NIDEK AFC-230 fundus camera · 45° FOV · modified Davis grading: 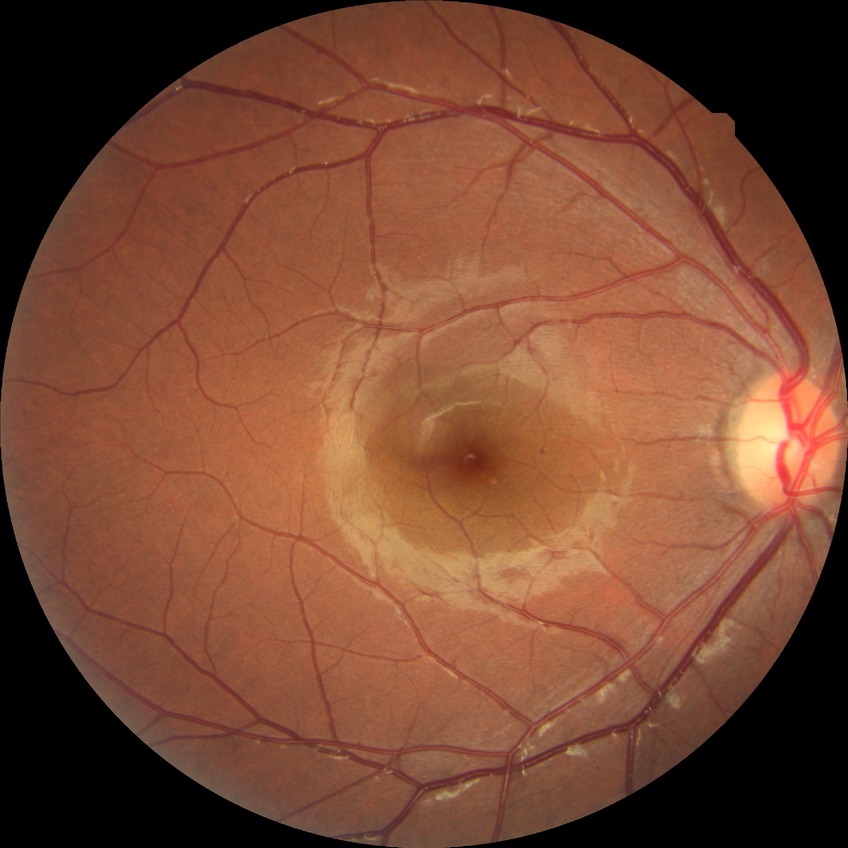
Retinopathy grade: simple diabetic retinopathy.